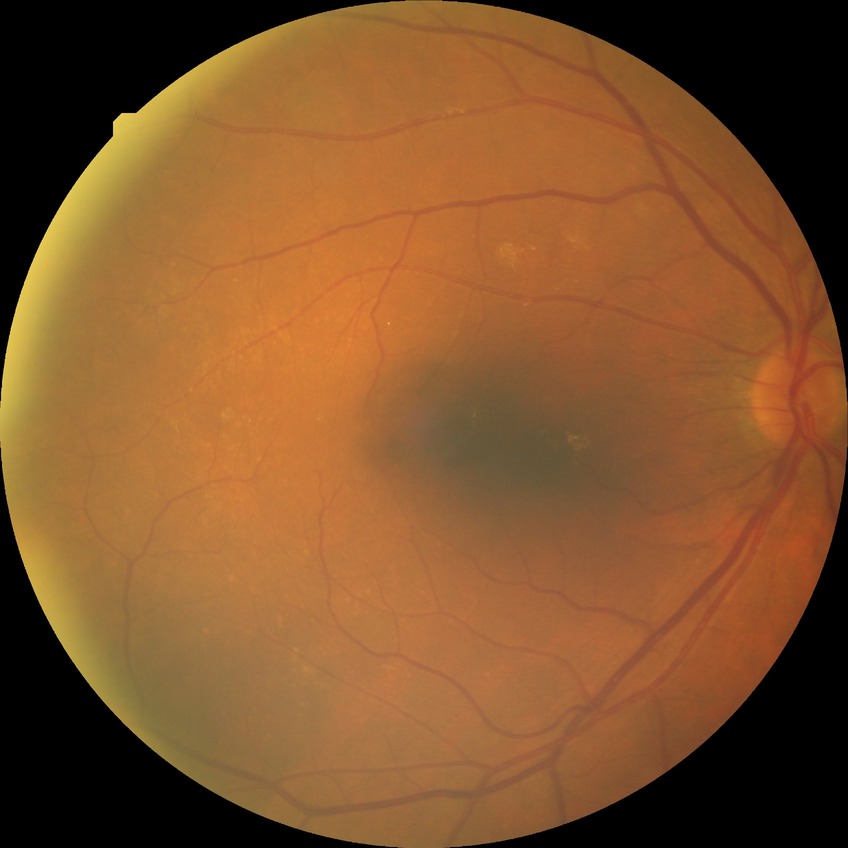

- modified Davis classification — simple diabetic retinopathy